Color fundus photograph: 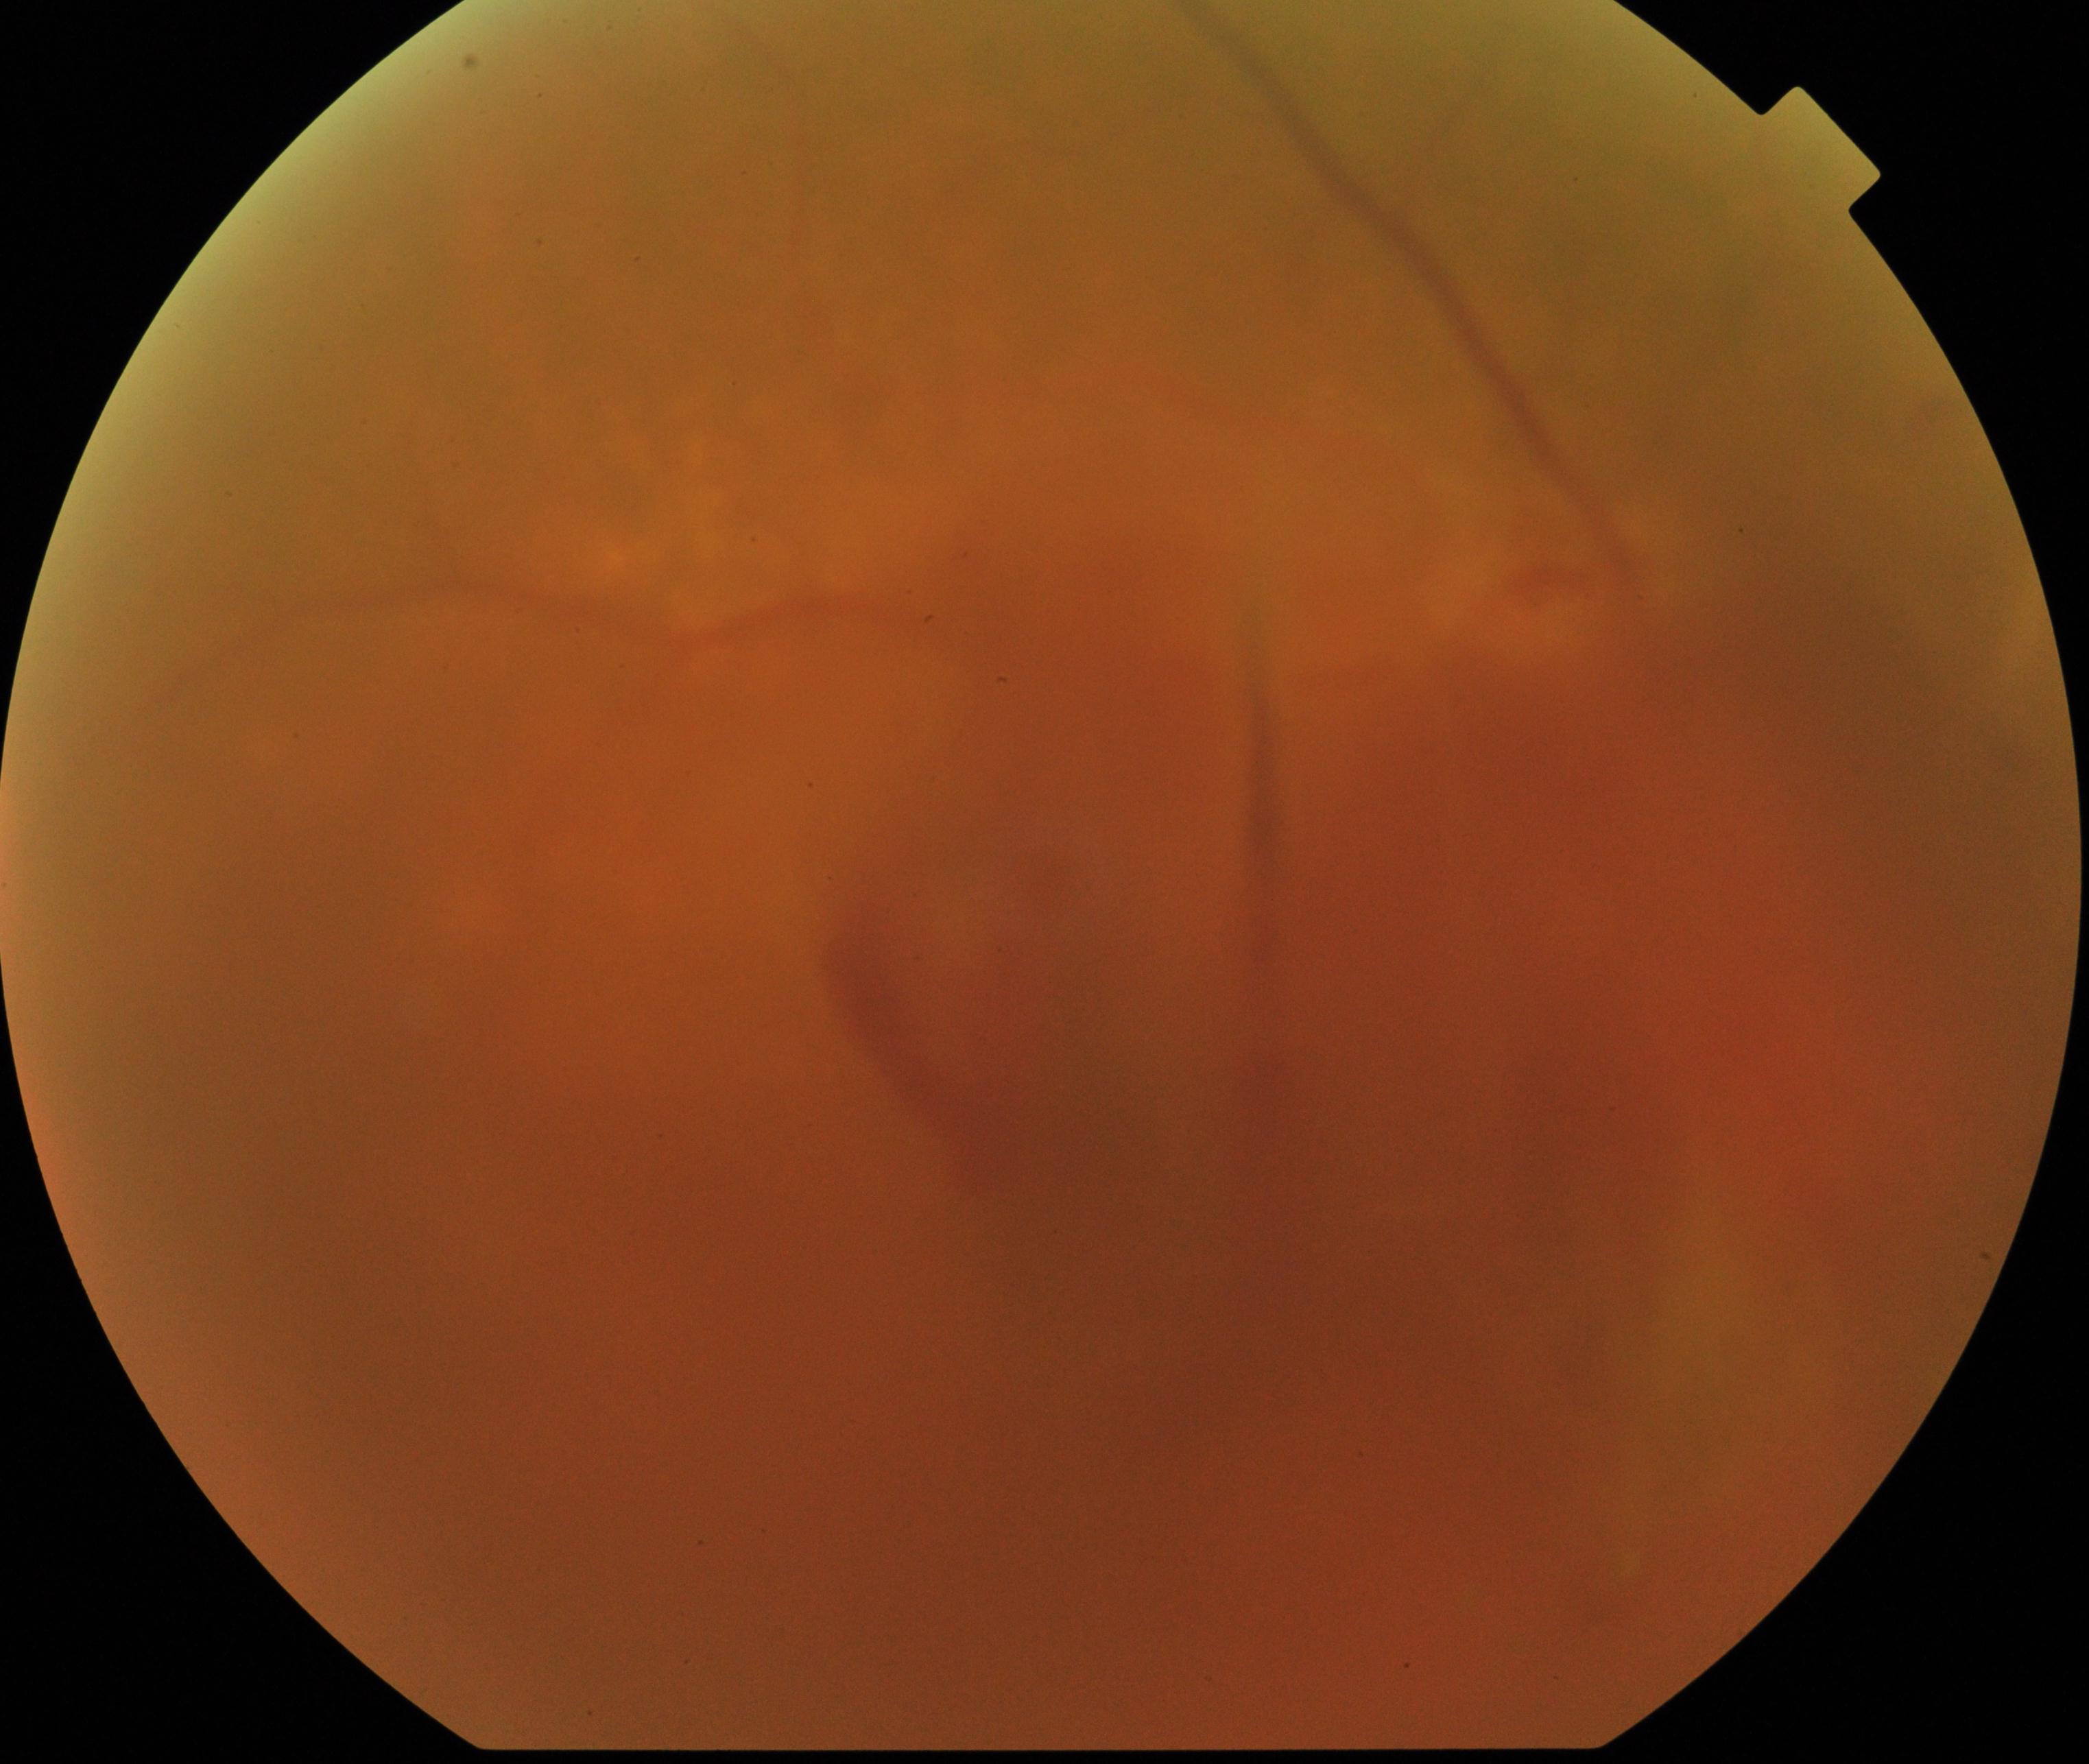

Image is blurred; retinal landmarks are largely obscured. Features suspicious for proliferative diabetic retinopathy.